Clarity RetCam 3, 130° FOV · pediatric wide-field fundus photograph: 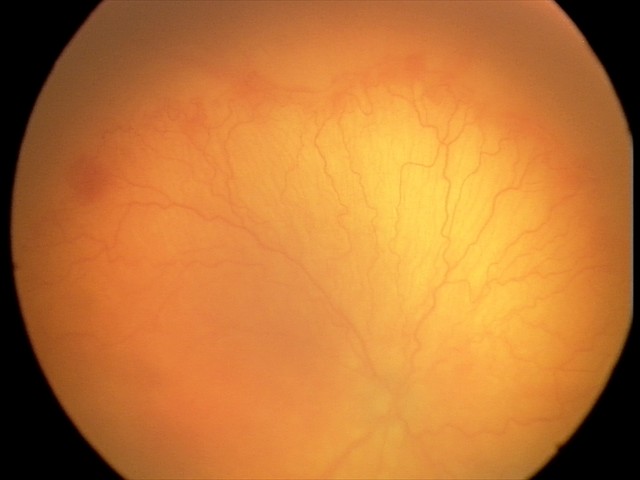
Plus disease present. Series diagnosed as aggressive retinopathy of prematurity (A-ROP) — rapidly progressive severe ROP with prominent plus disease, often without classic stage progression.